Wide-field fundus photograph of an infant:
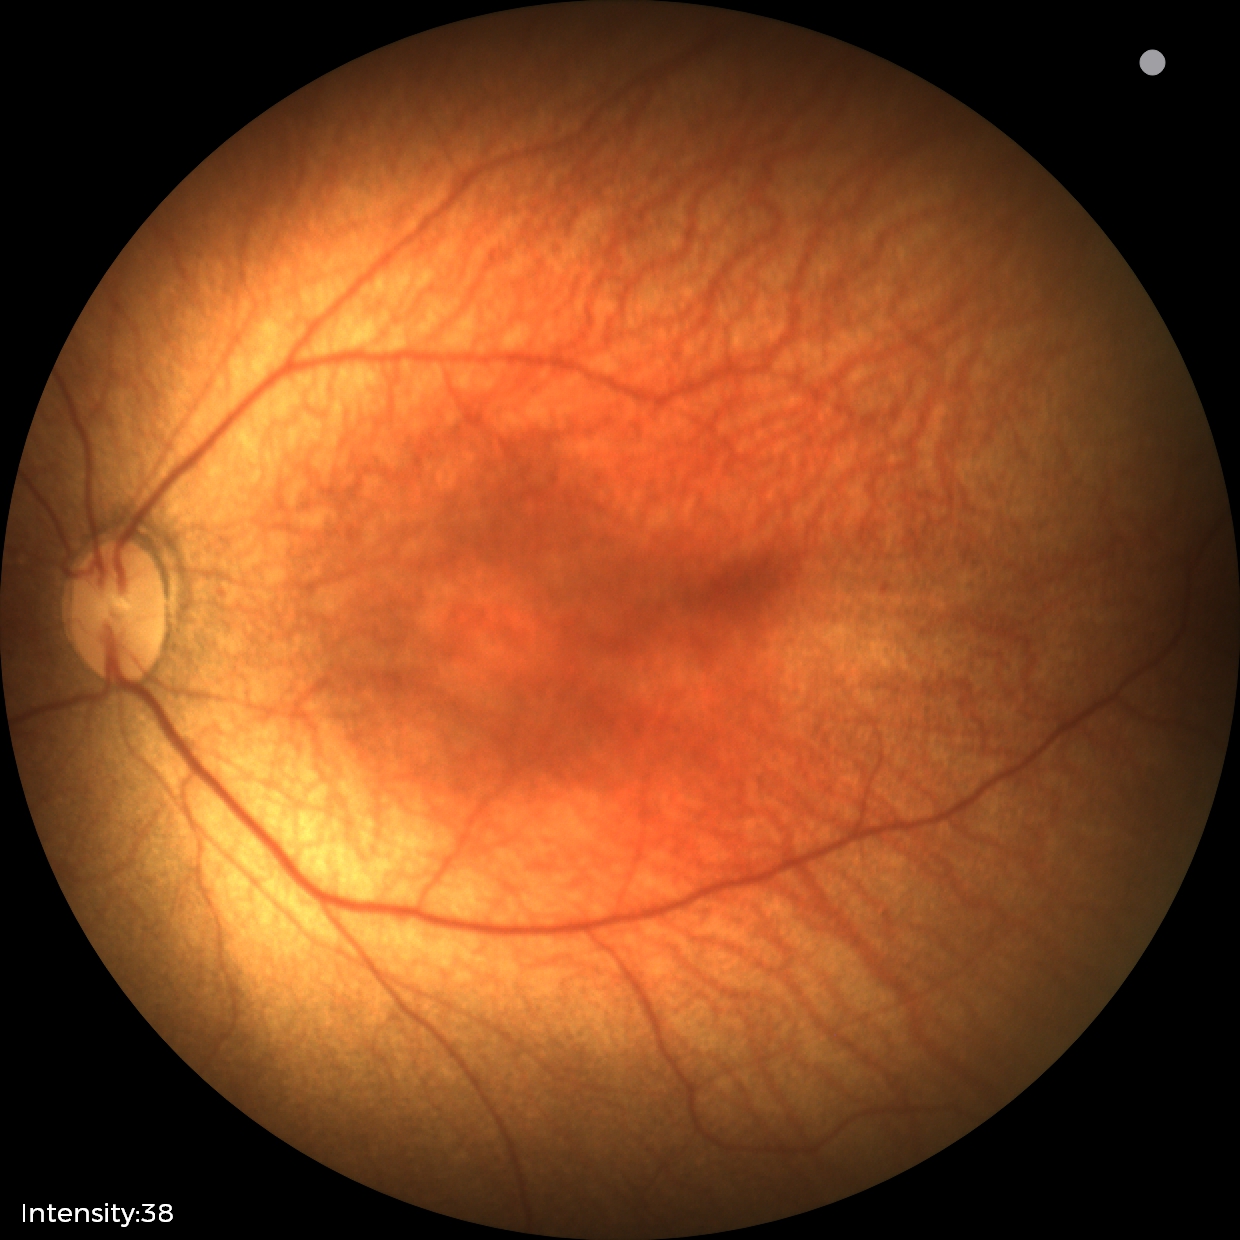

Screening diagnosis: status post retinopathy of prematurity.